Fundus photo · FOV: 45 degrees — 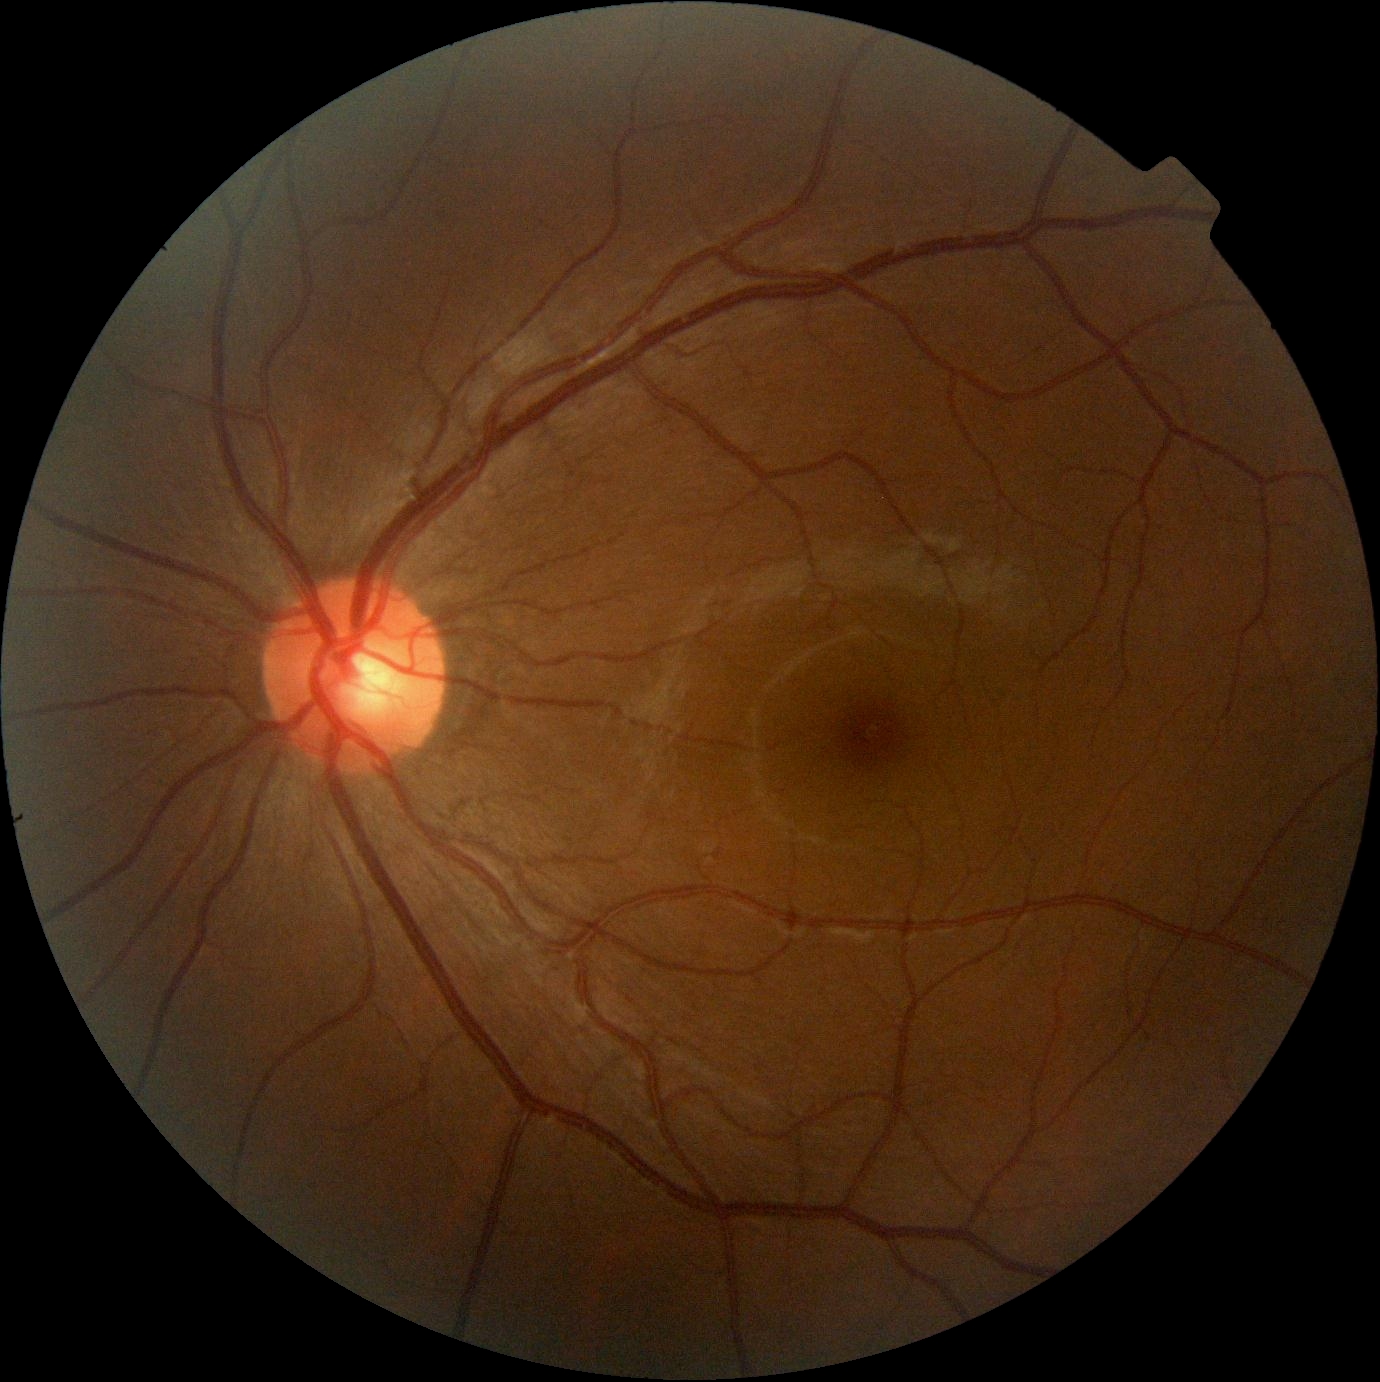
DR: no apparent diabetic retinopathy (grade 0) — no visible signs of diabetic retinopathy.
No diabetic retinal disease findings.